848 by 848 pixels; nonmydriatic fundus photograph; NIDEK AFC-230 fundus camera.
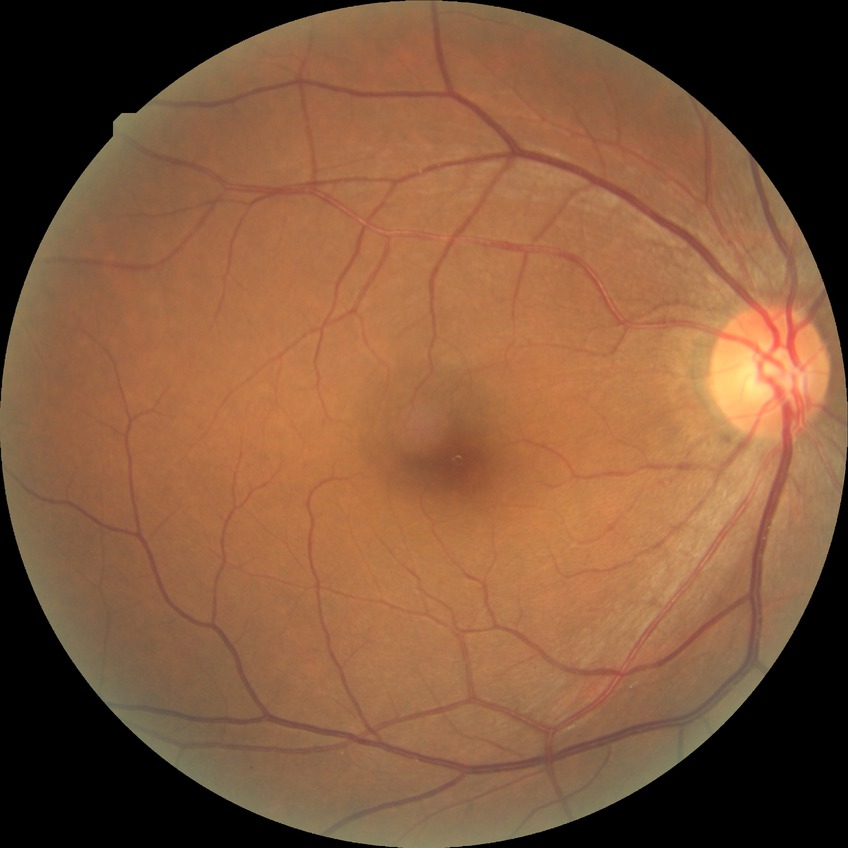 Diabetic retinopathy (DR): NDR (no diabetic retinopathy).